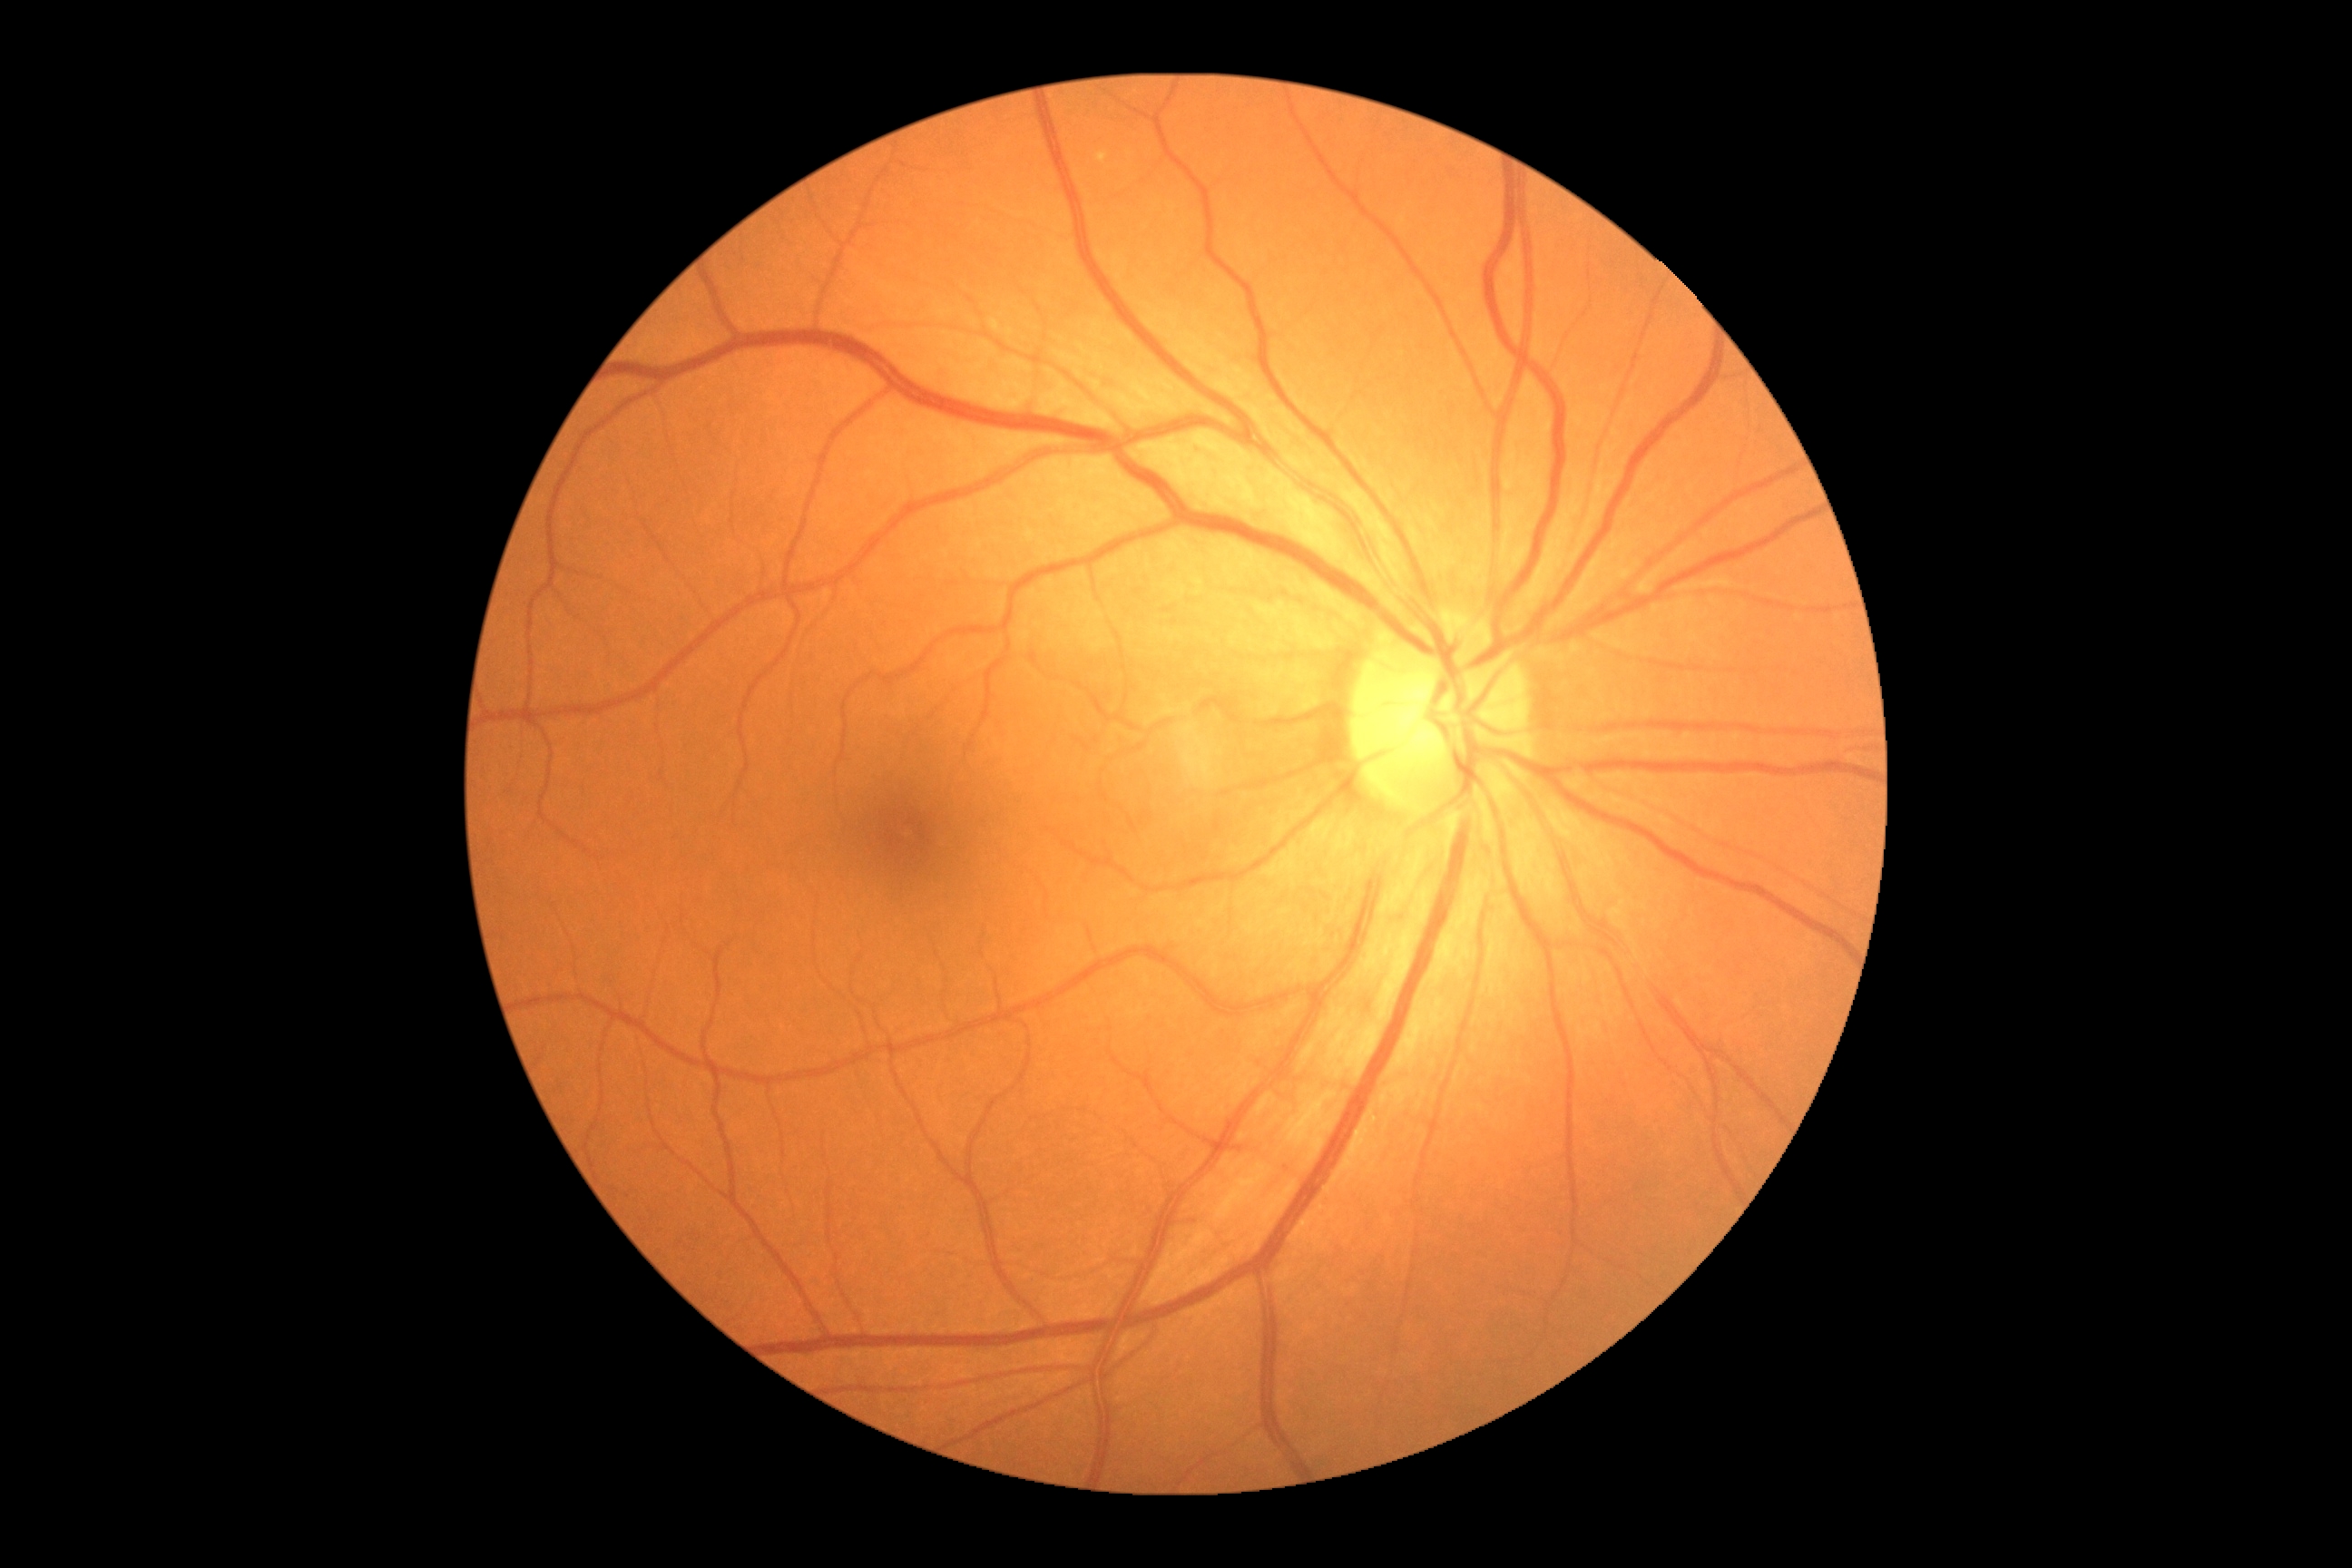
{
  "dr_grade": "0 (no apparent retinopathy)"
}